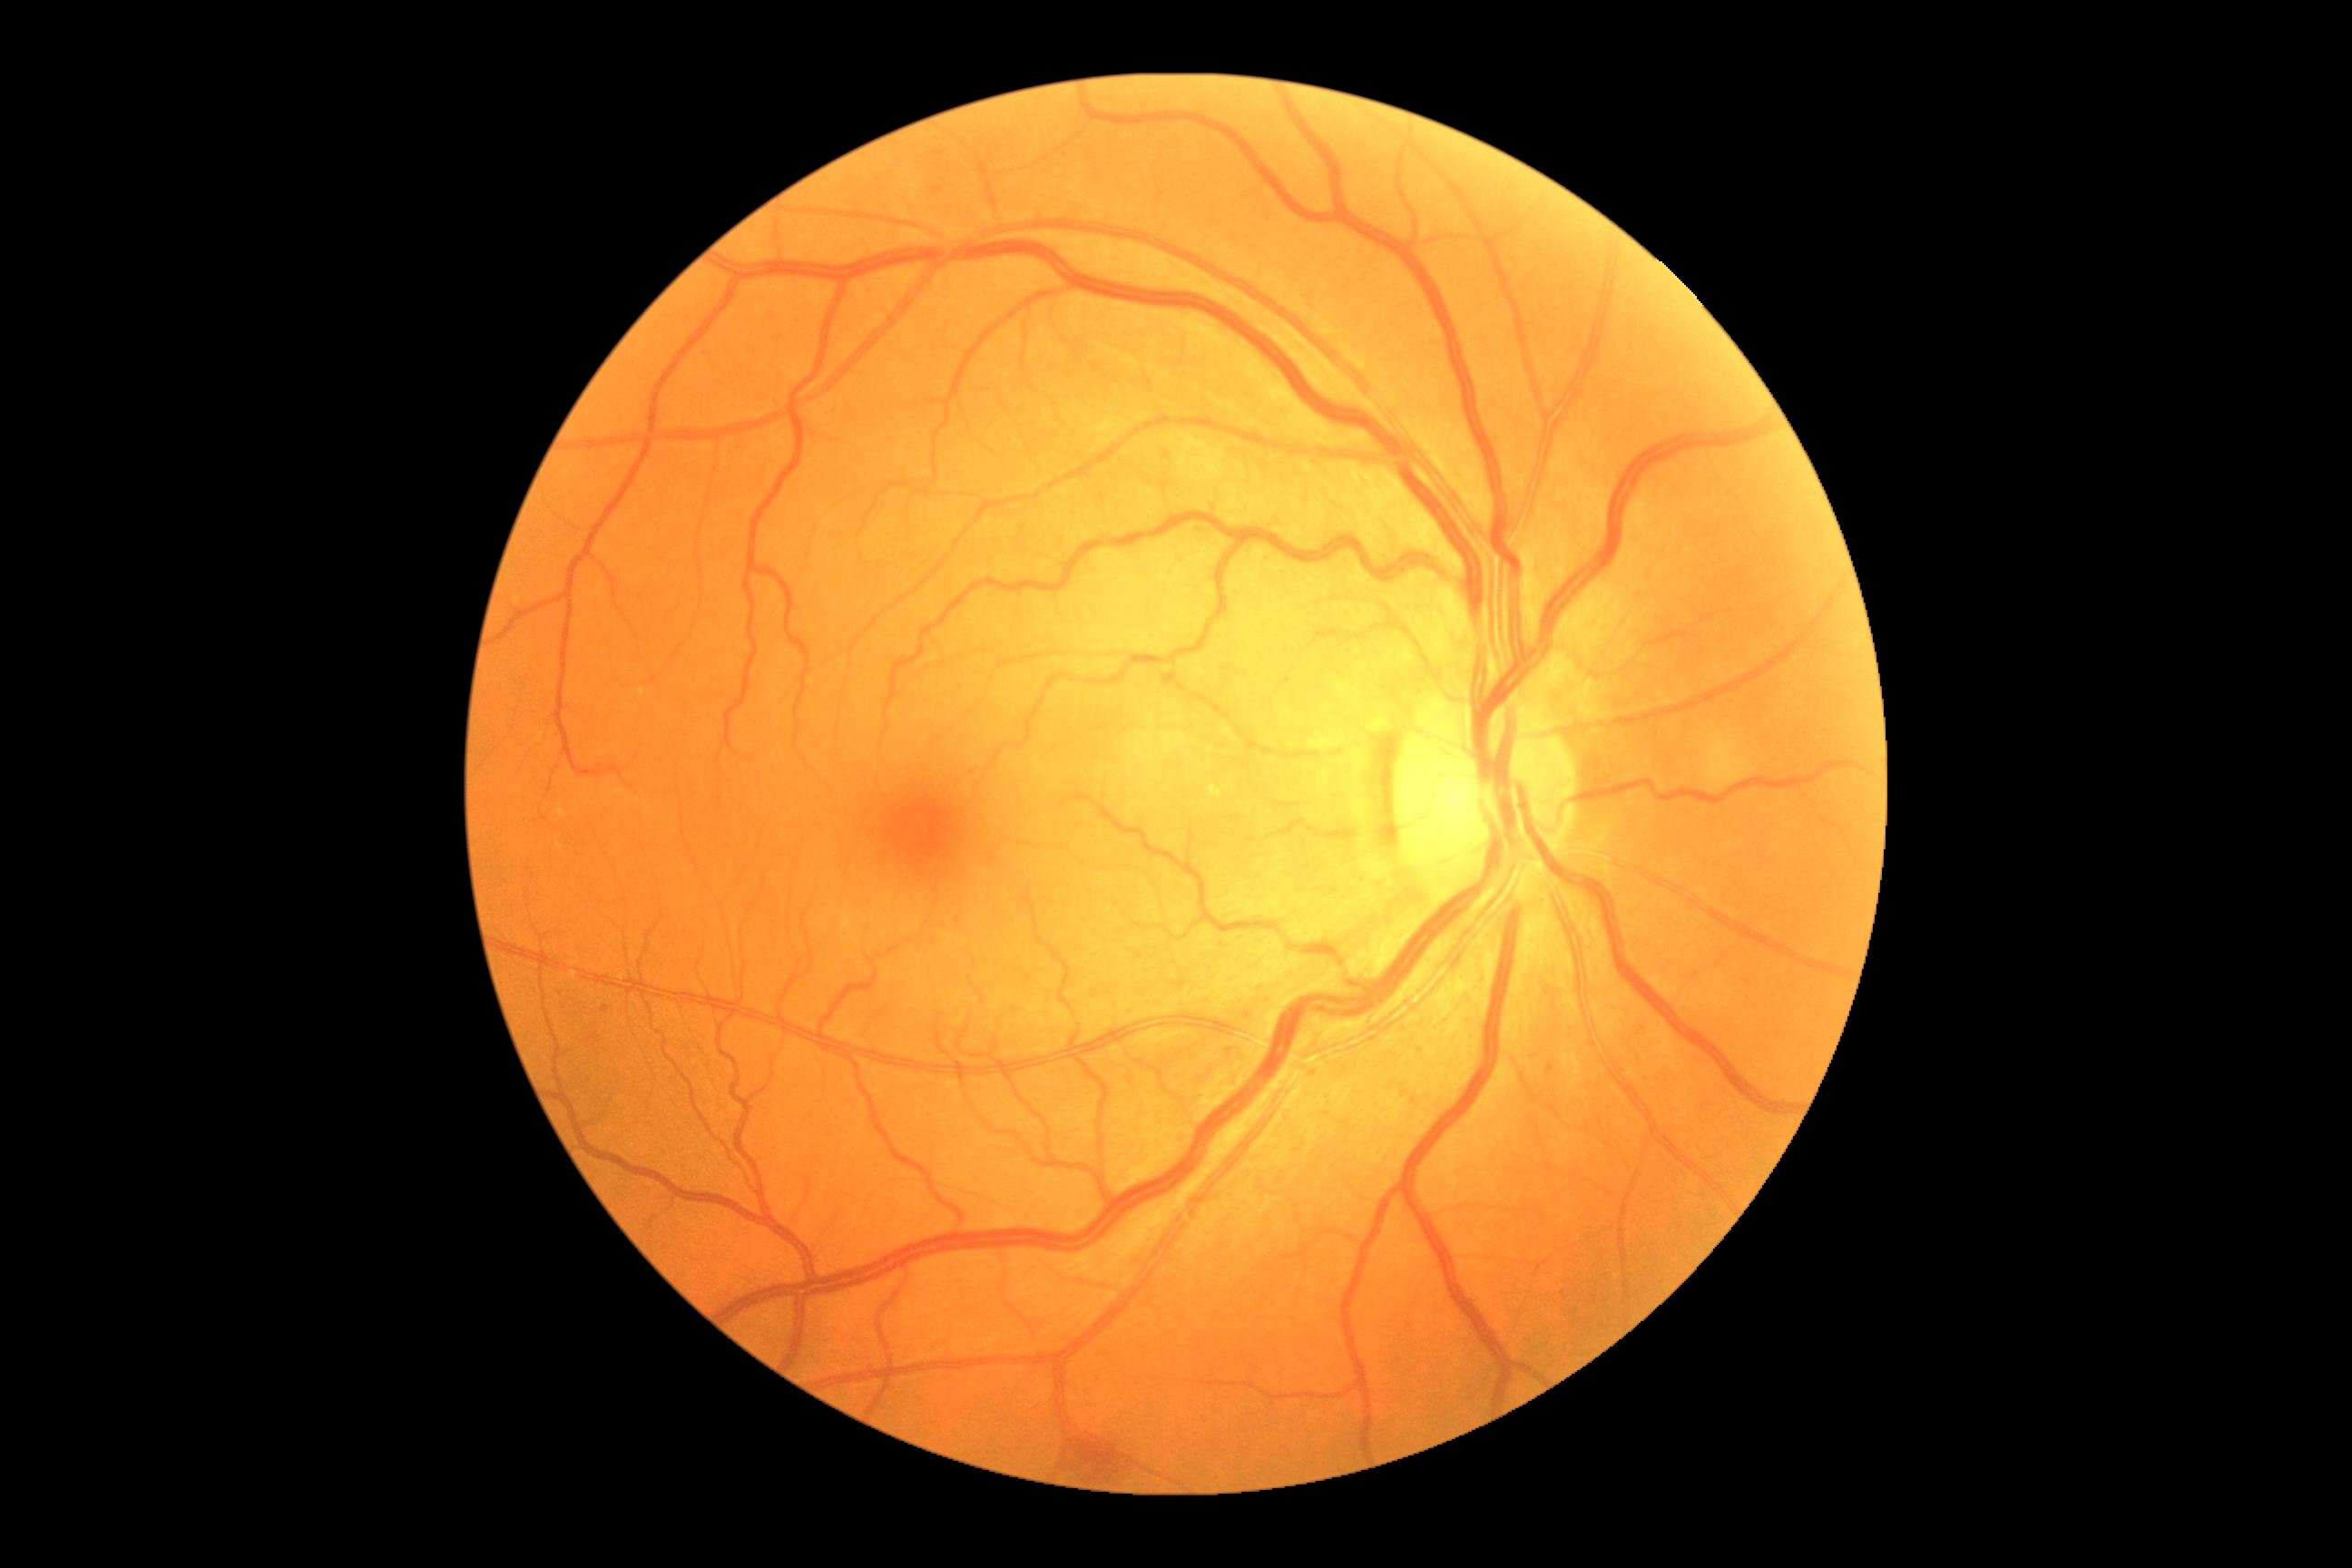
diabetic retinopathy (DR) = moderate non-proliferative diabetic retinopathy (grade 2).